Color fundus photograph · FOV: 45 degrees · 2184x1691:
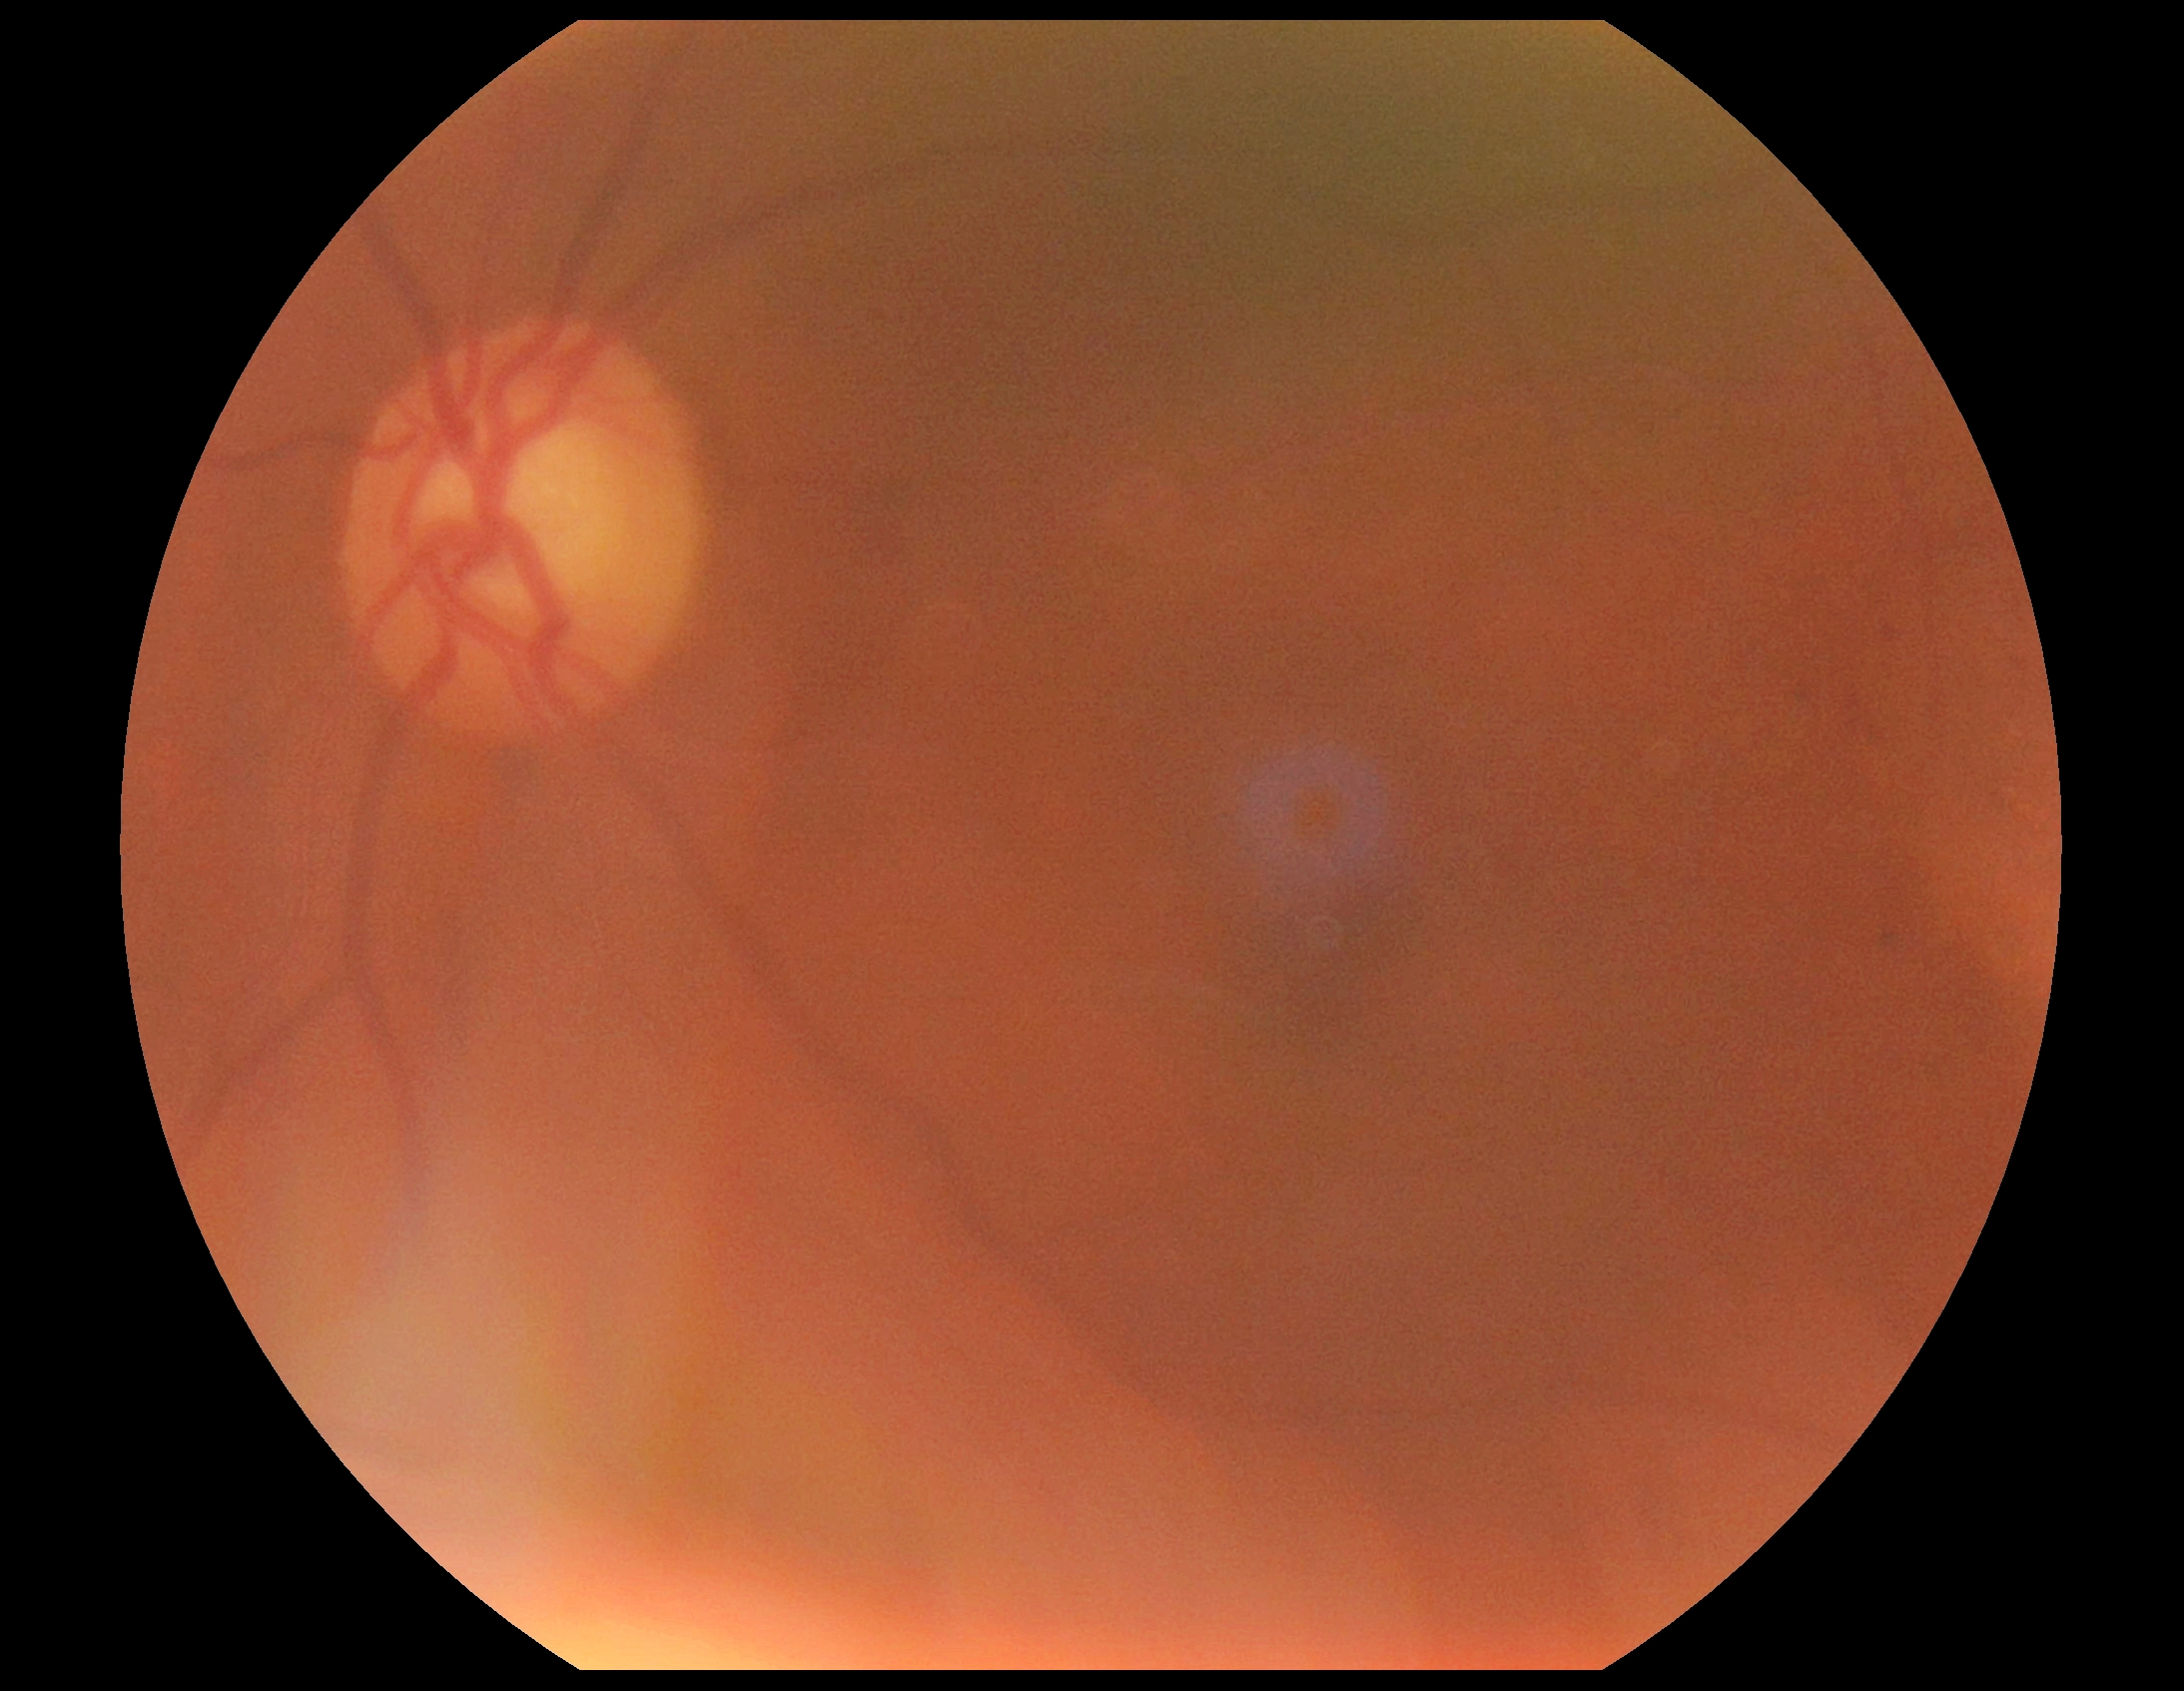

dr_grade: grade 2 (moderate NPDR)